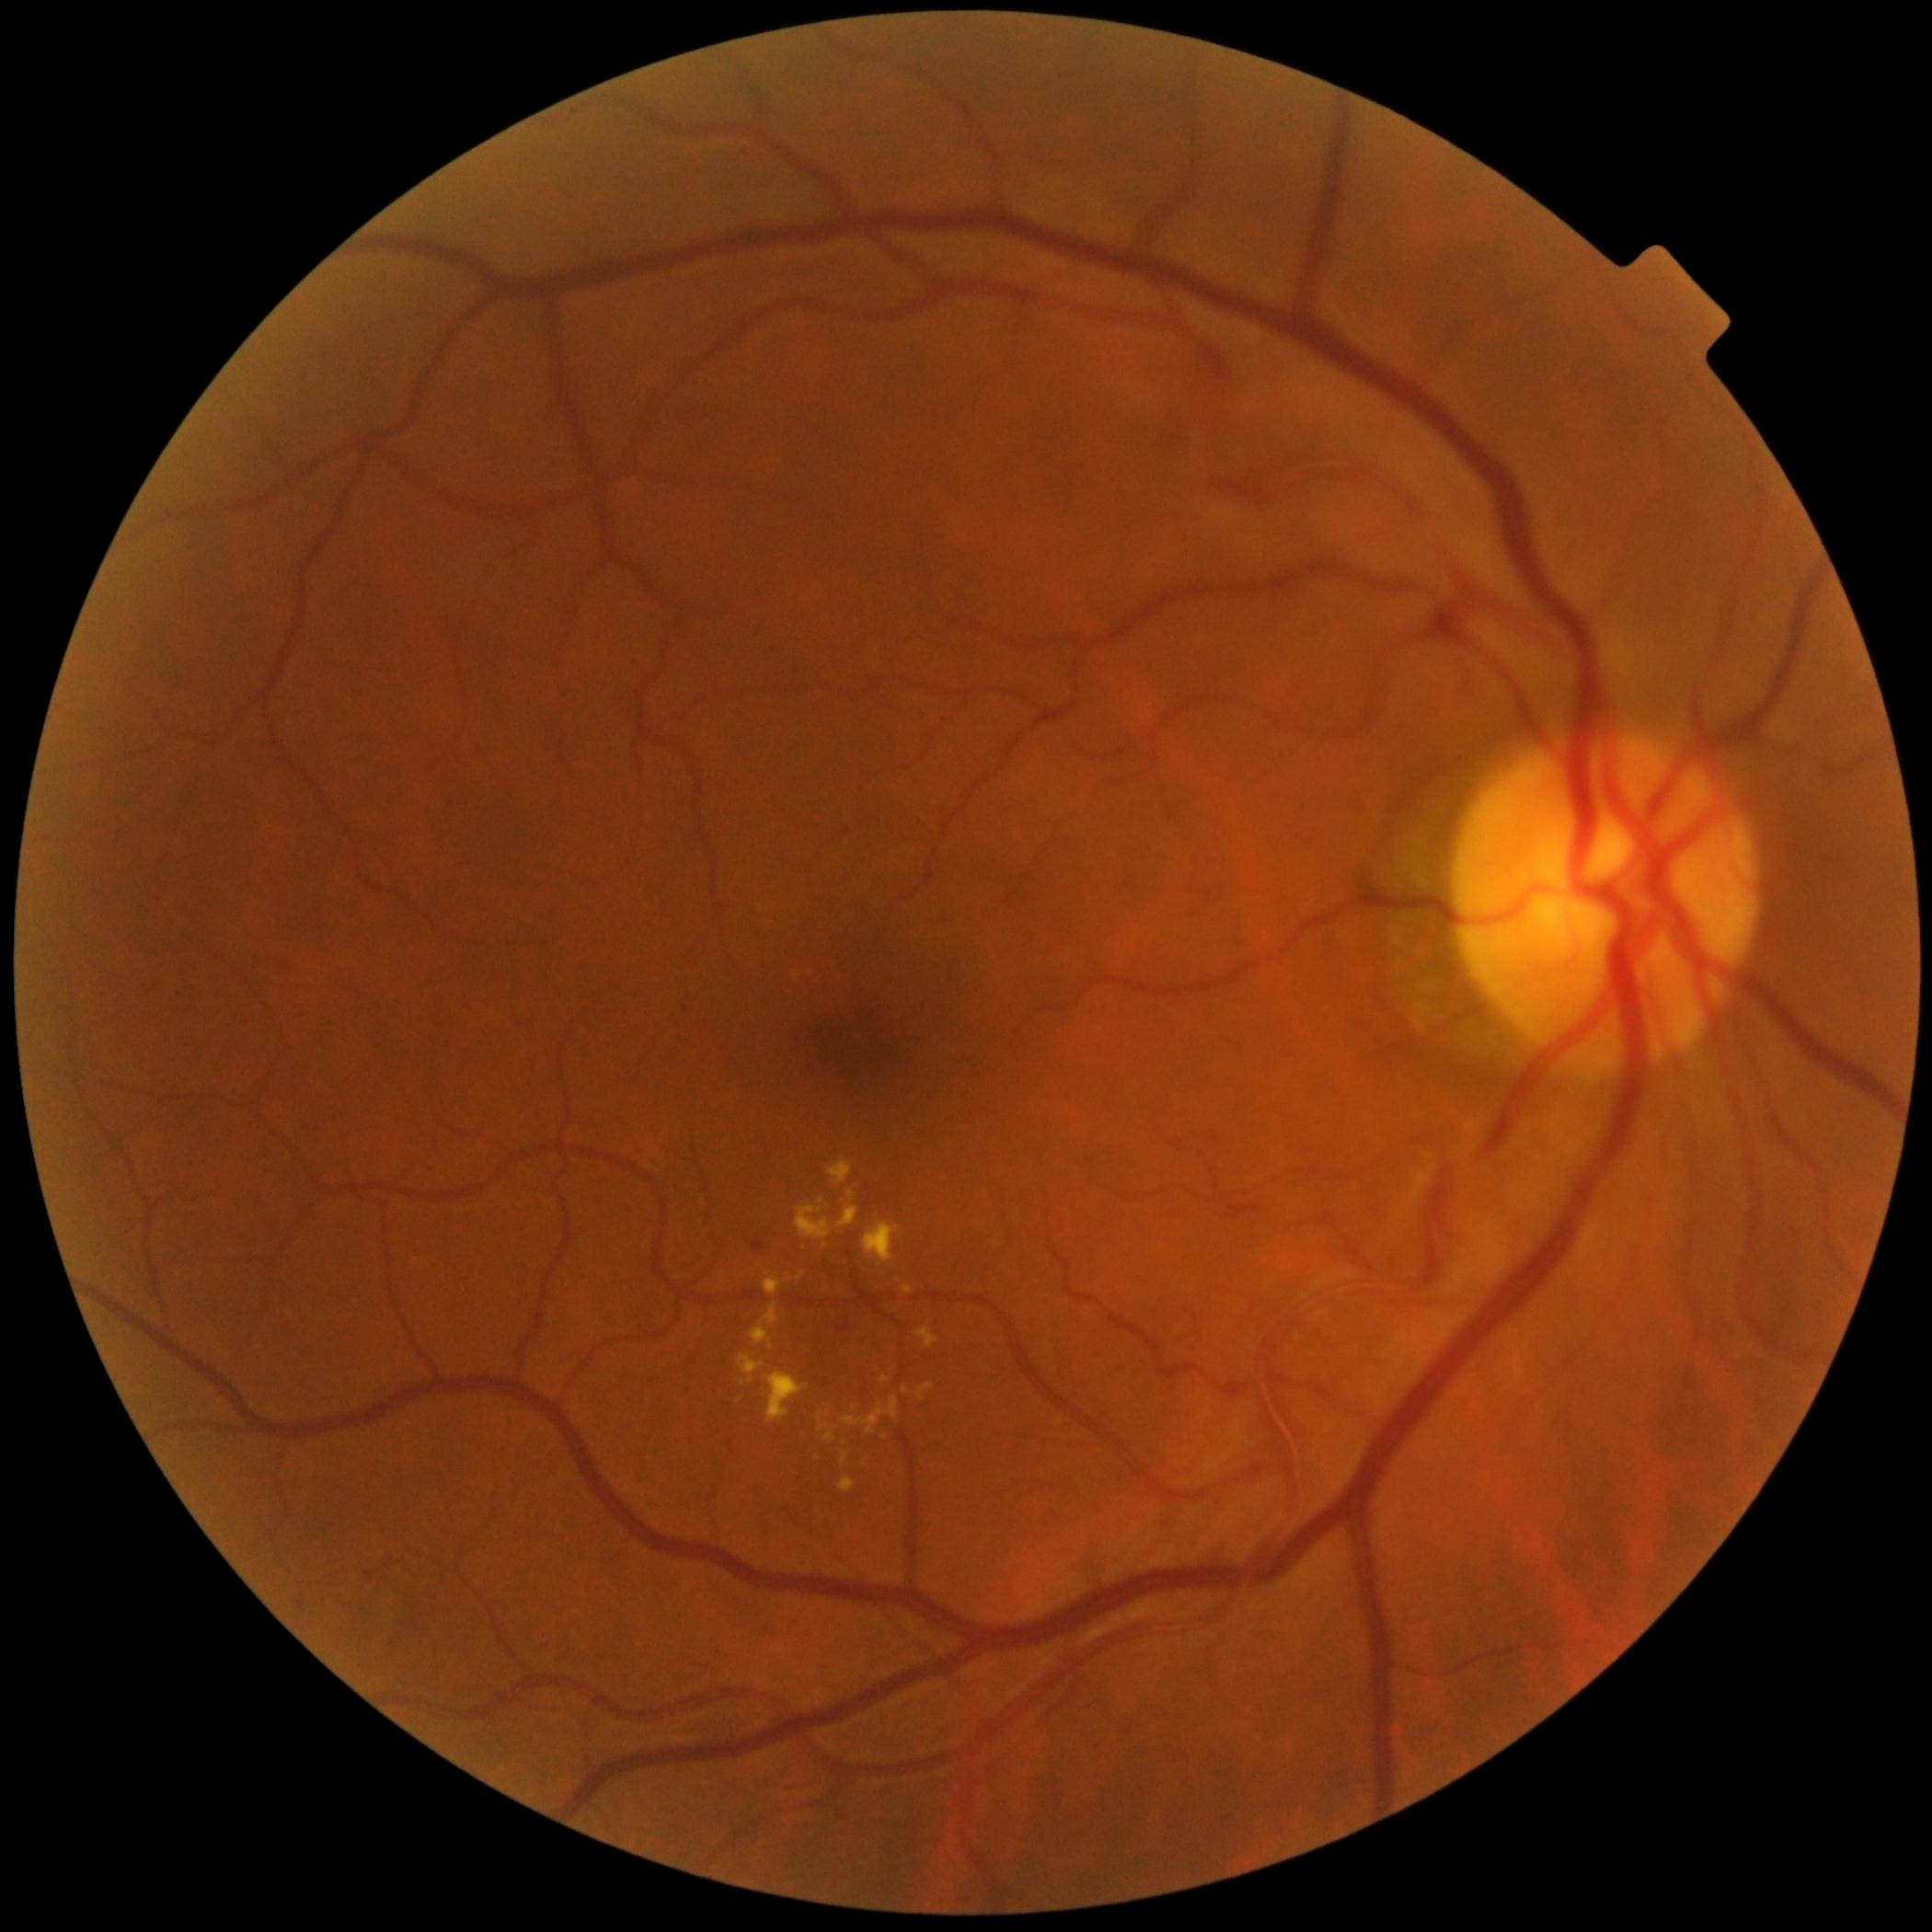 Retinopathy grade: moderate NPDR (2); non-proliferative diabetic retinopathy
Selected lesions:
• hard exudates (partial): [750, 1303, 780, 1350]; [825, 1433, 836, 1443]; [840, 1476, 855, 1493]; [765, 1275, 782, 1295]; [737, 1353, 764, 1383]; [880, 1377, 890, 1385]; [842, 1396, 900, 1435]; [903, 1386, 909, 1394]; [849, 1190, 855, 1201]; [916, 1327, 938, 1350]
• Hard exudates (small, approximate centers) near 740, 1400